Color fundus photograph: 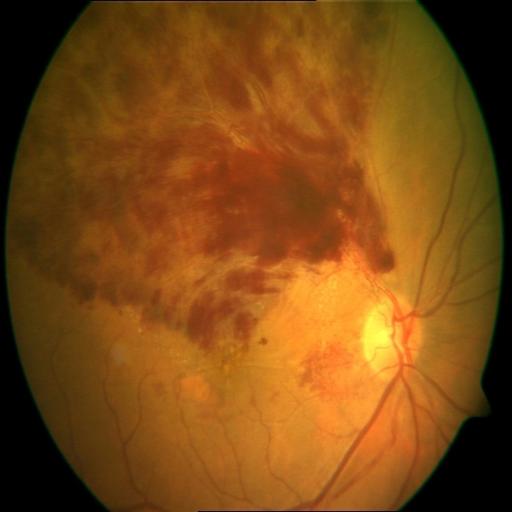 Impression:
- branch retinal vein occlusion